1932 by 1932 pixels. Color fundus photograph: 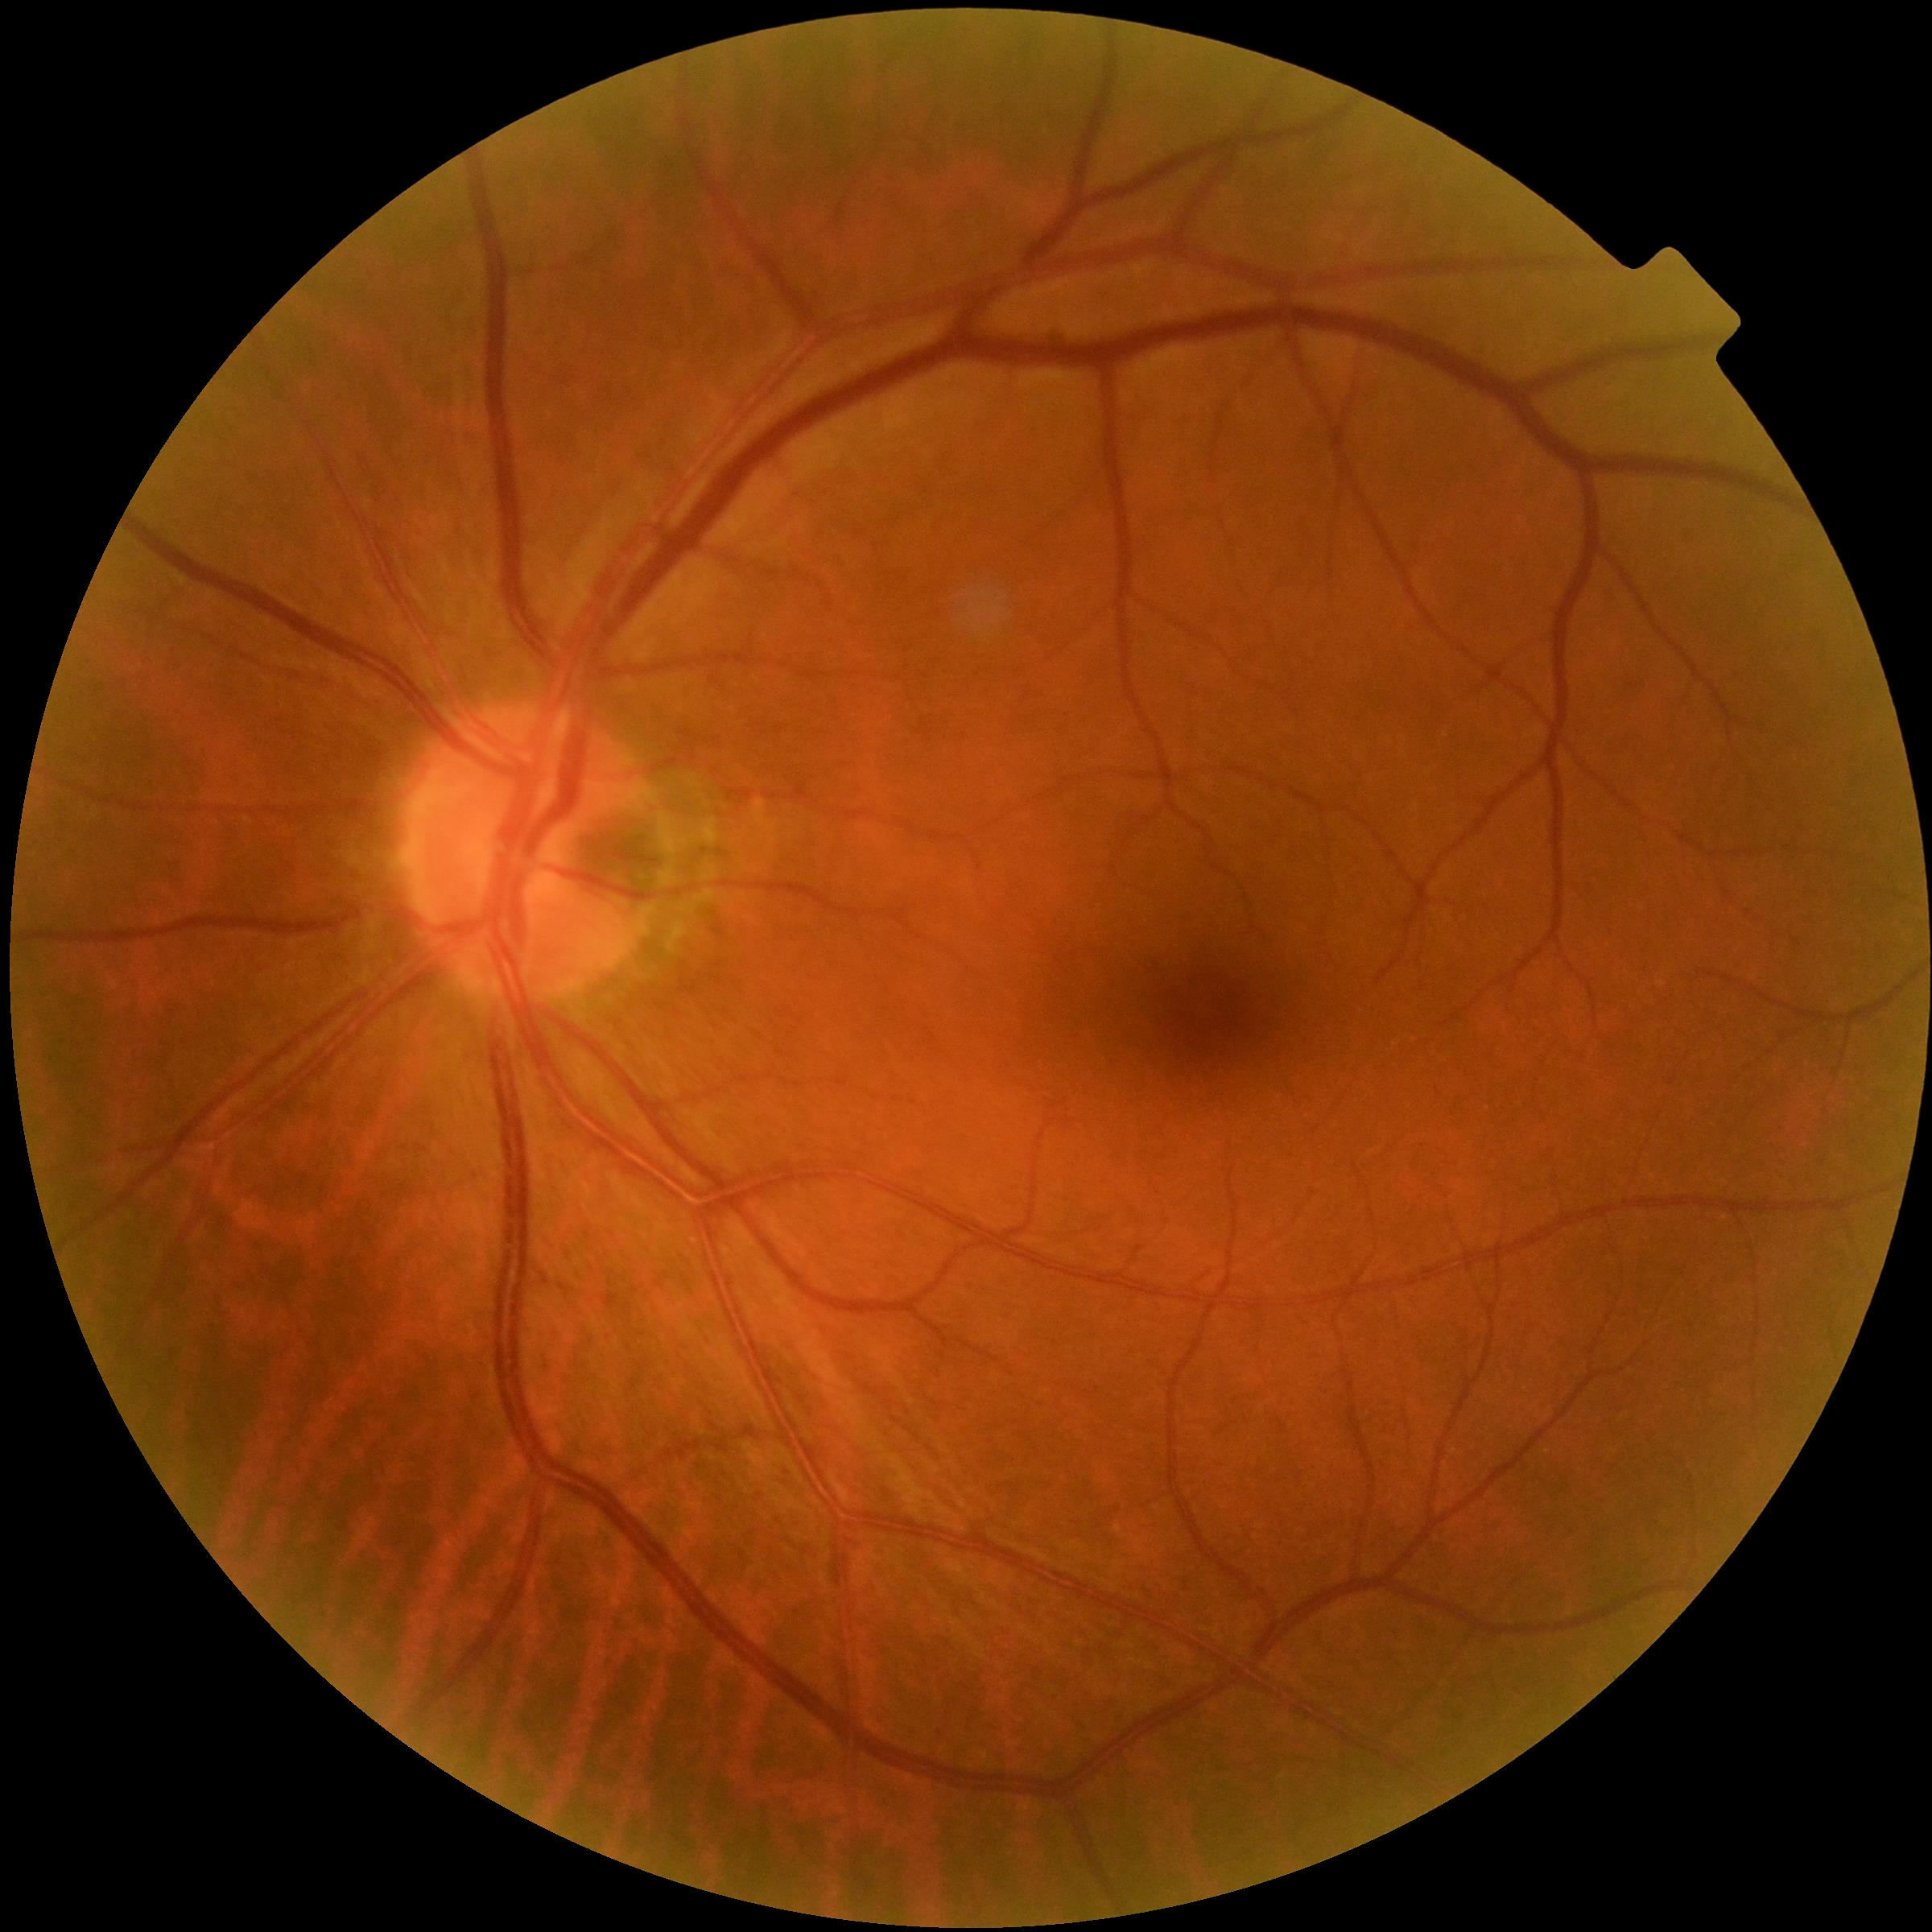

Diabetic retinopathy (DR): grade 0 (no apparent retinopathy). No apparent diabetic retinopathy.